Wide-field contact fundus photograph of an infant: 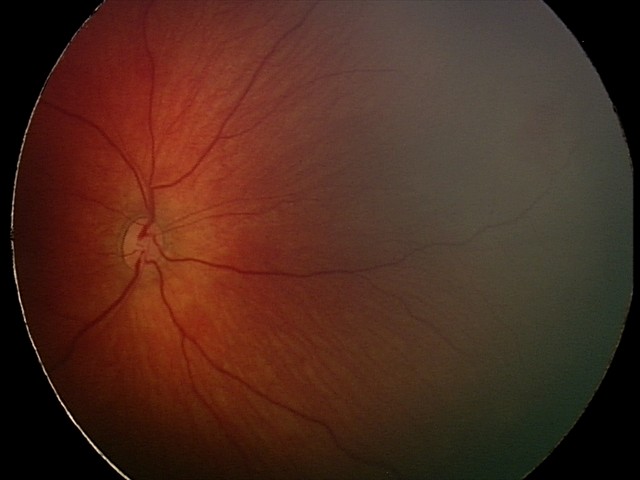
Diagnosis from this screening exam: retinal hemorrhages.